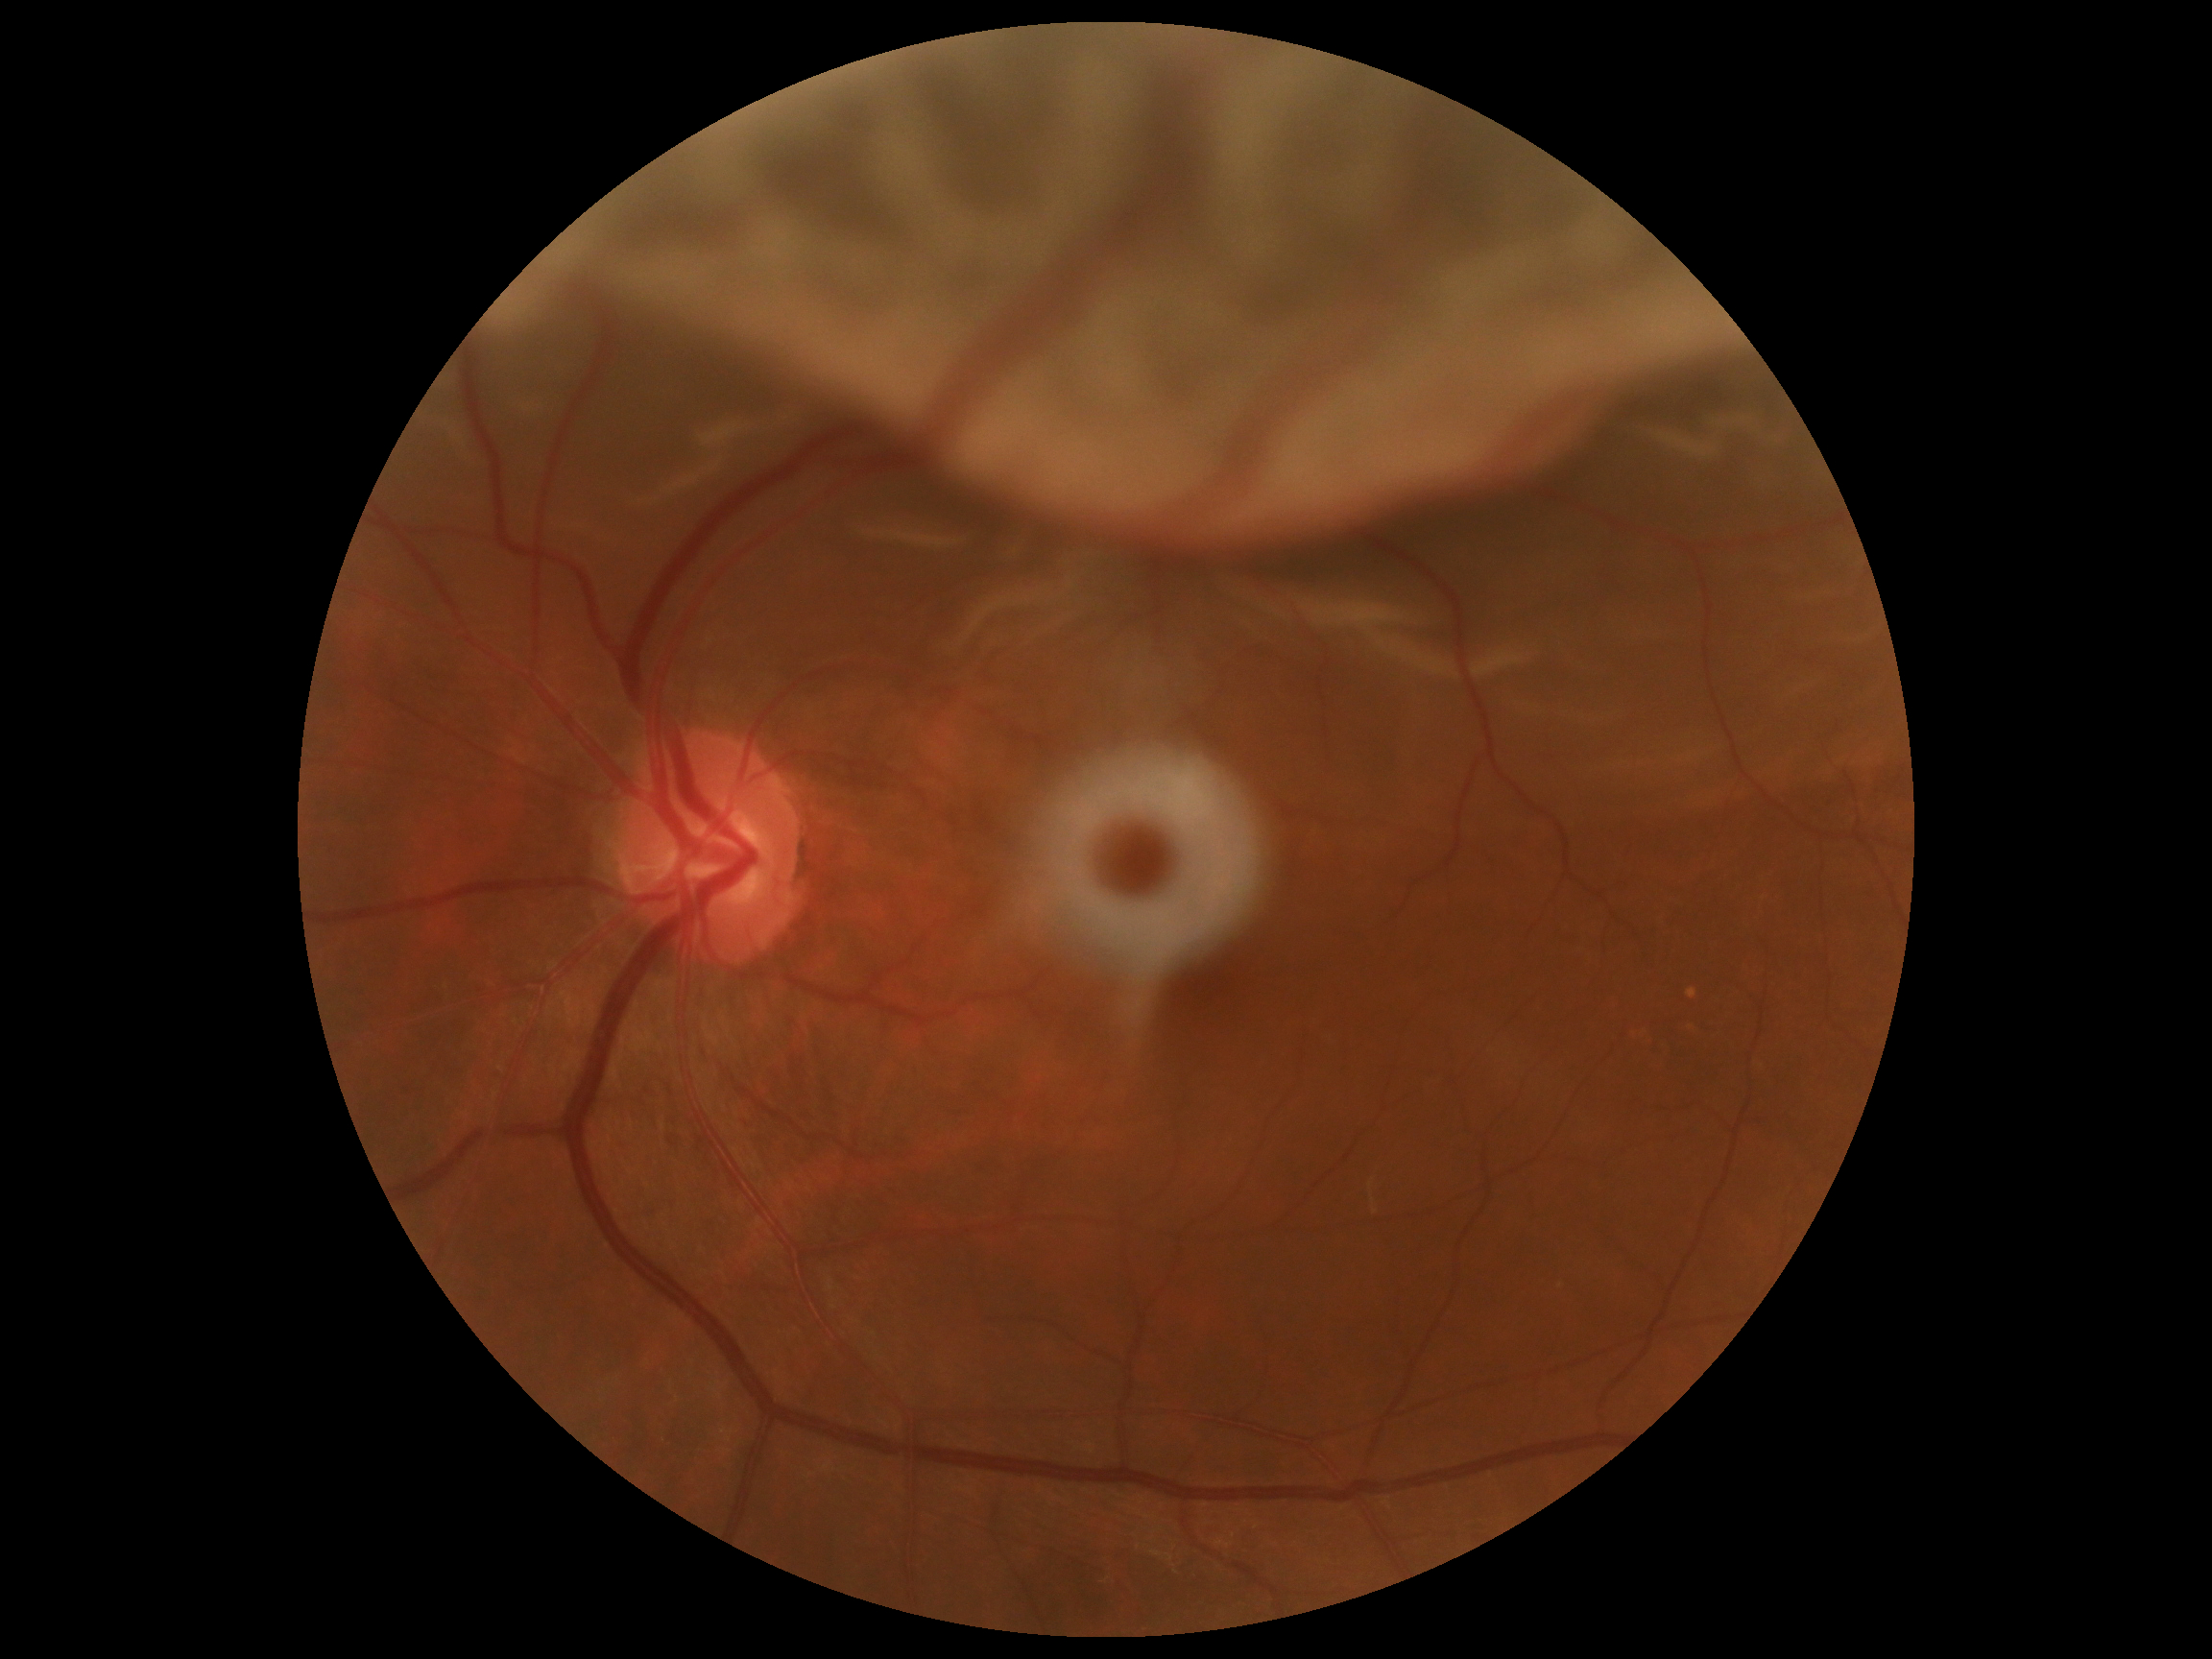
DR severity: 4 — neovascularization and/or vitreous/pre-retinal hemorrhage.
DR class: proliferative diabetic retinopathy.